RetCam wide-field infant fundus image: 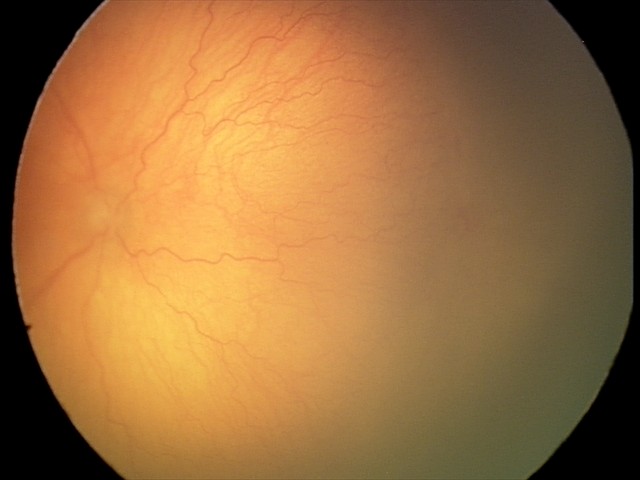 Screening examination consistent with aggressive retinopathy of prematurity (A-ROP). With plus disease.